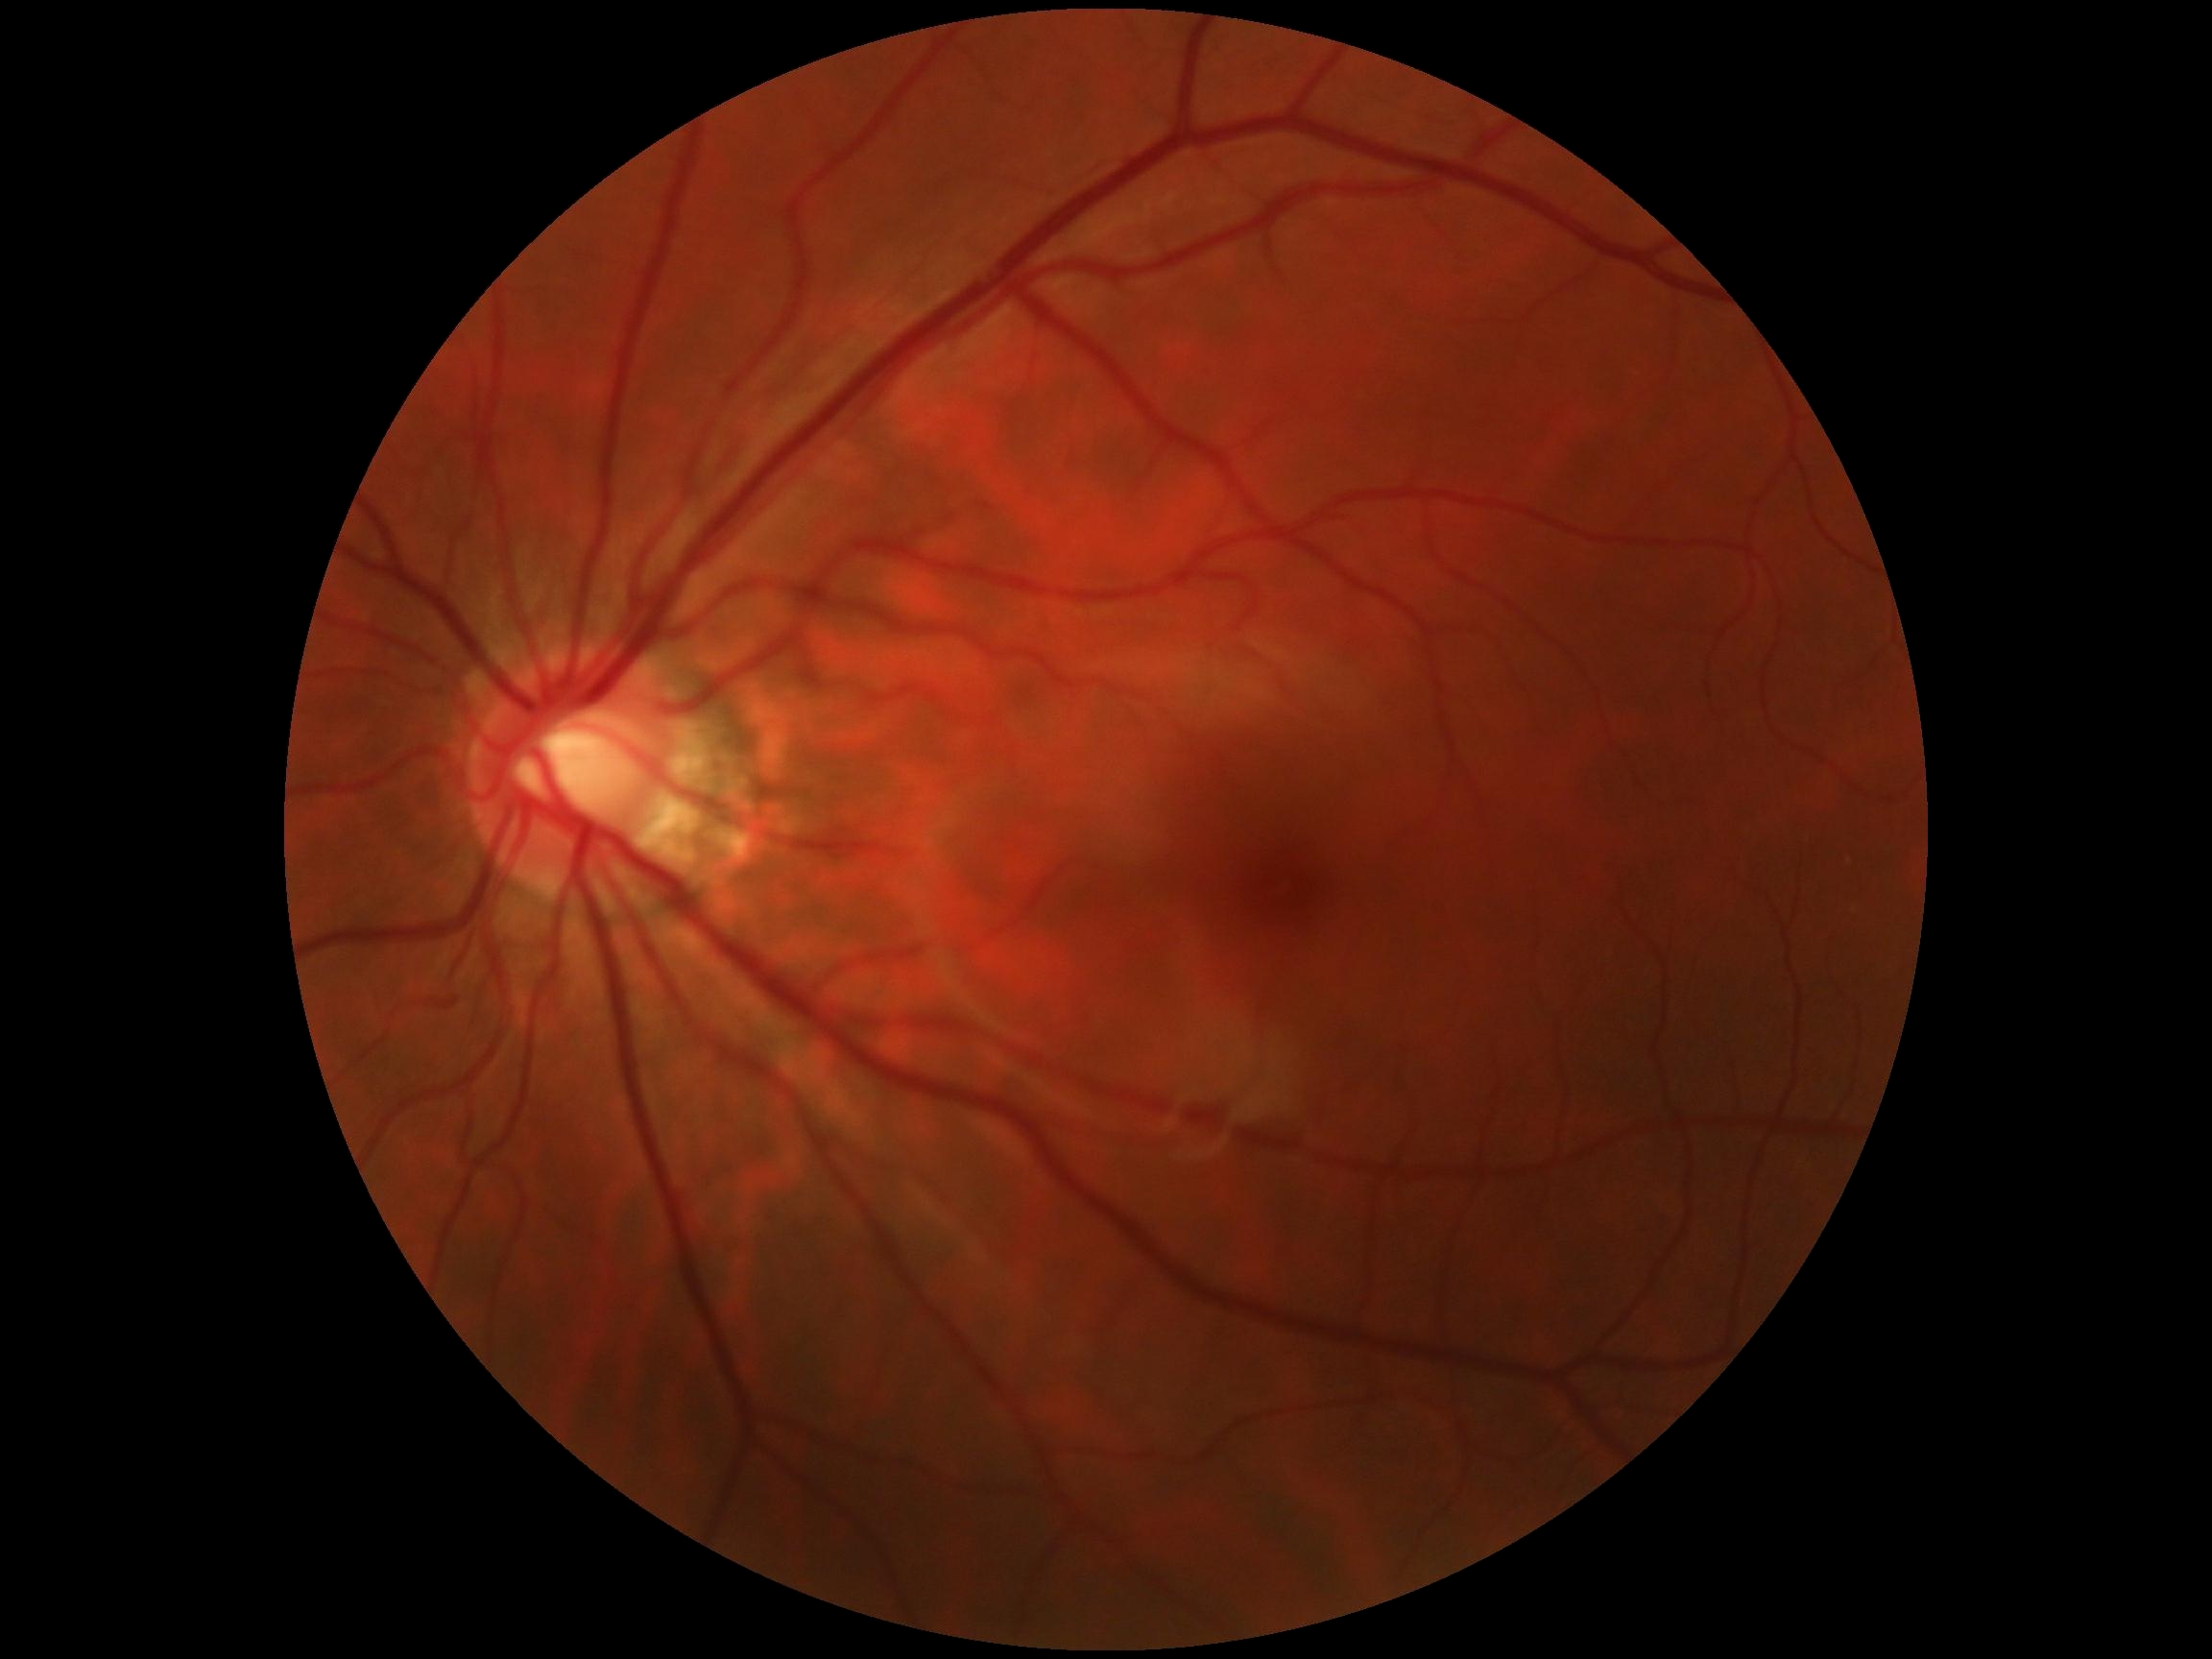

Diabetic retinopathy (DR): 0/4. No apparent diabetic retinopathy.